Captured on a Nidek AFC-330 fundus camera:
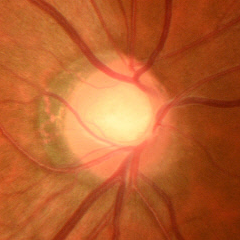

Glaucomatous optic neuropathy is present. This fundus photograph shows early glaucomatous optic neuropathy.